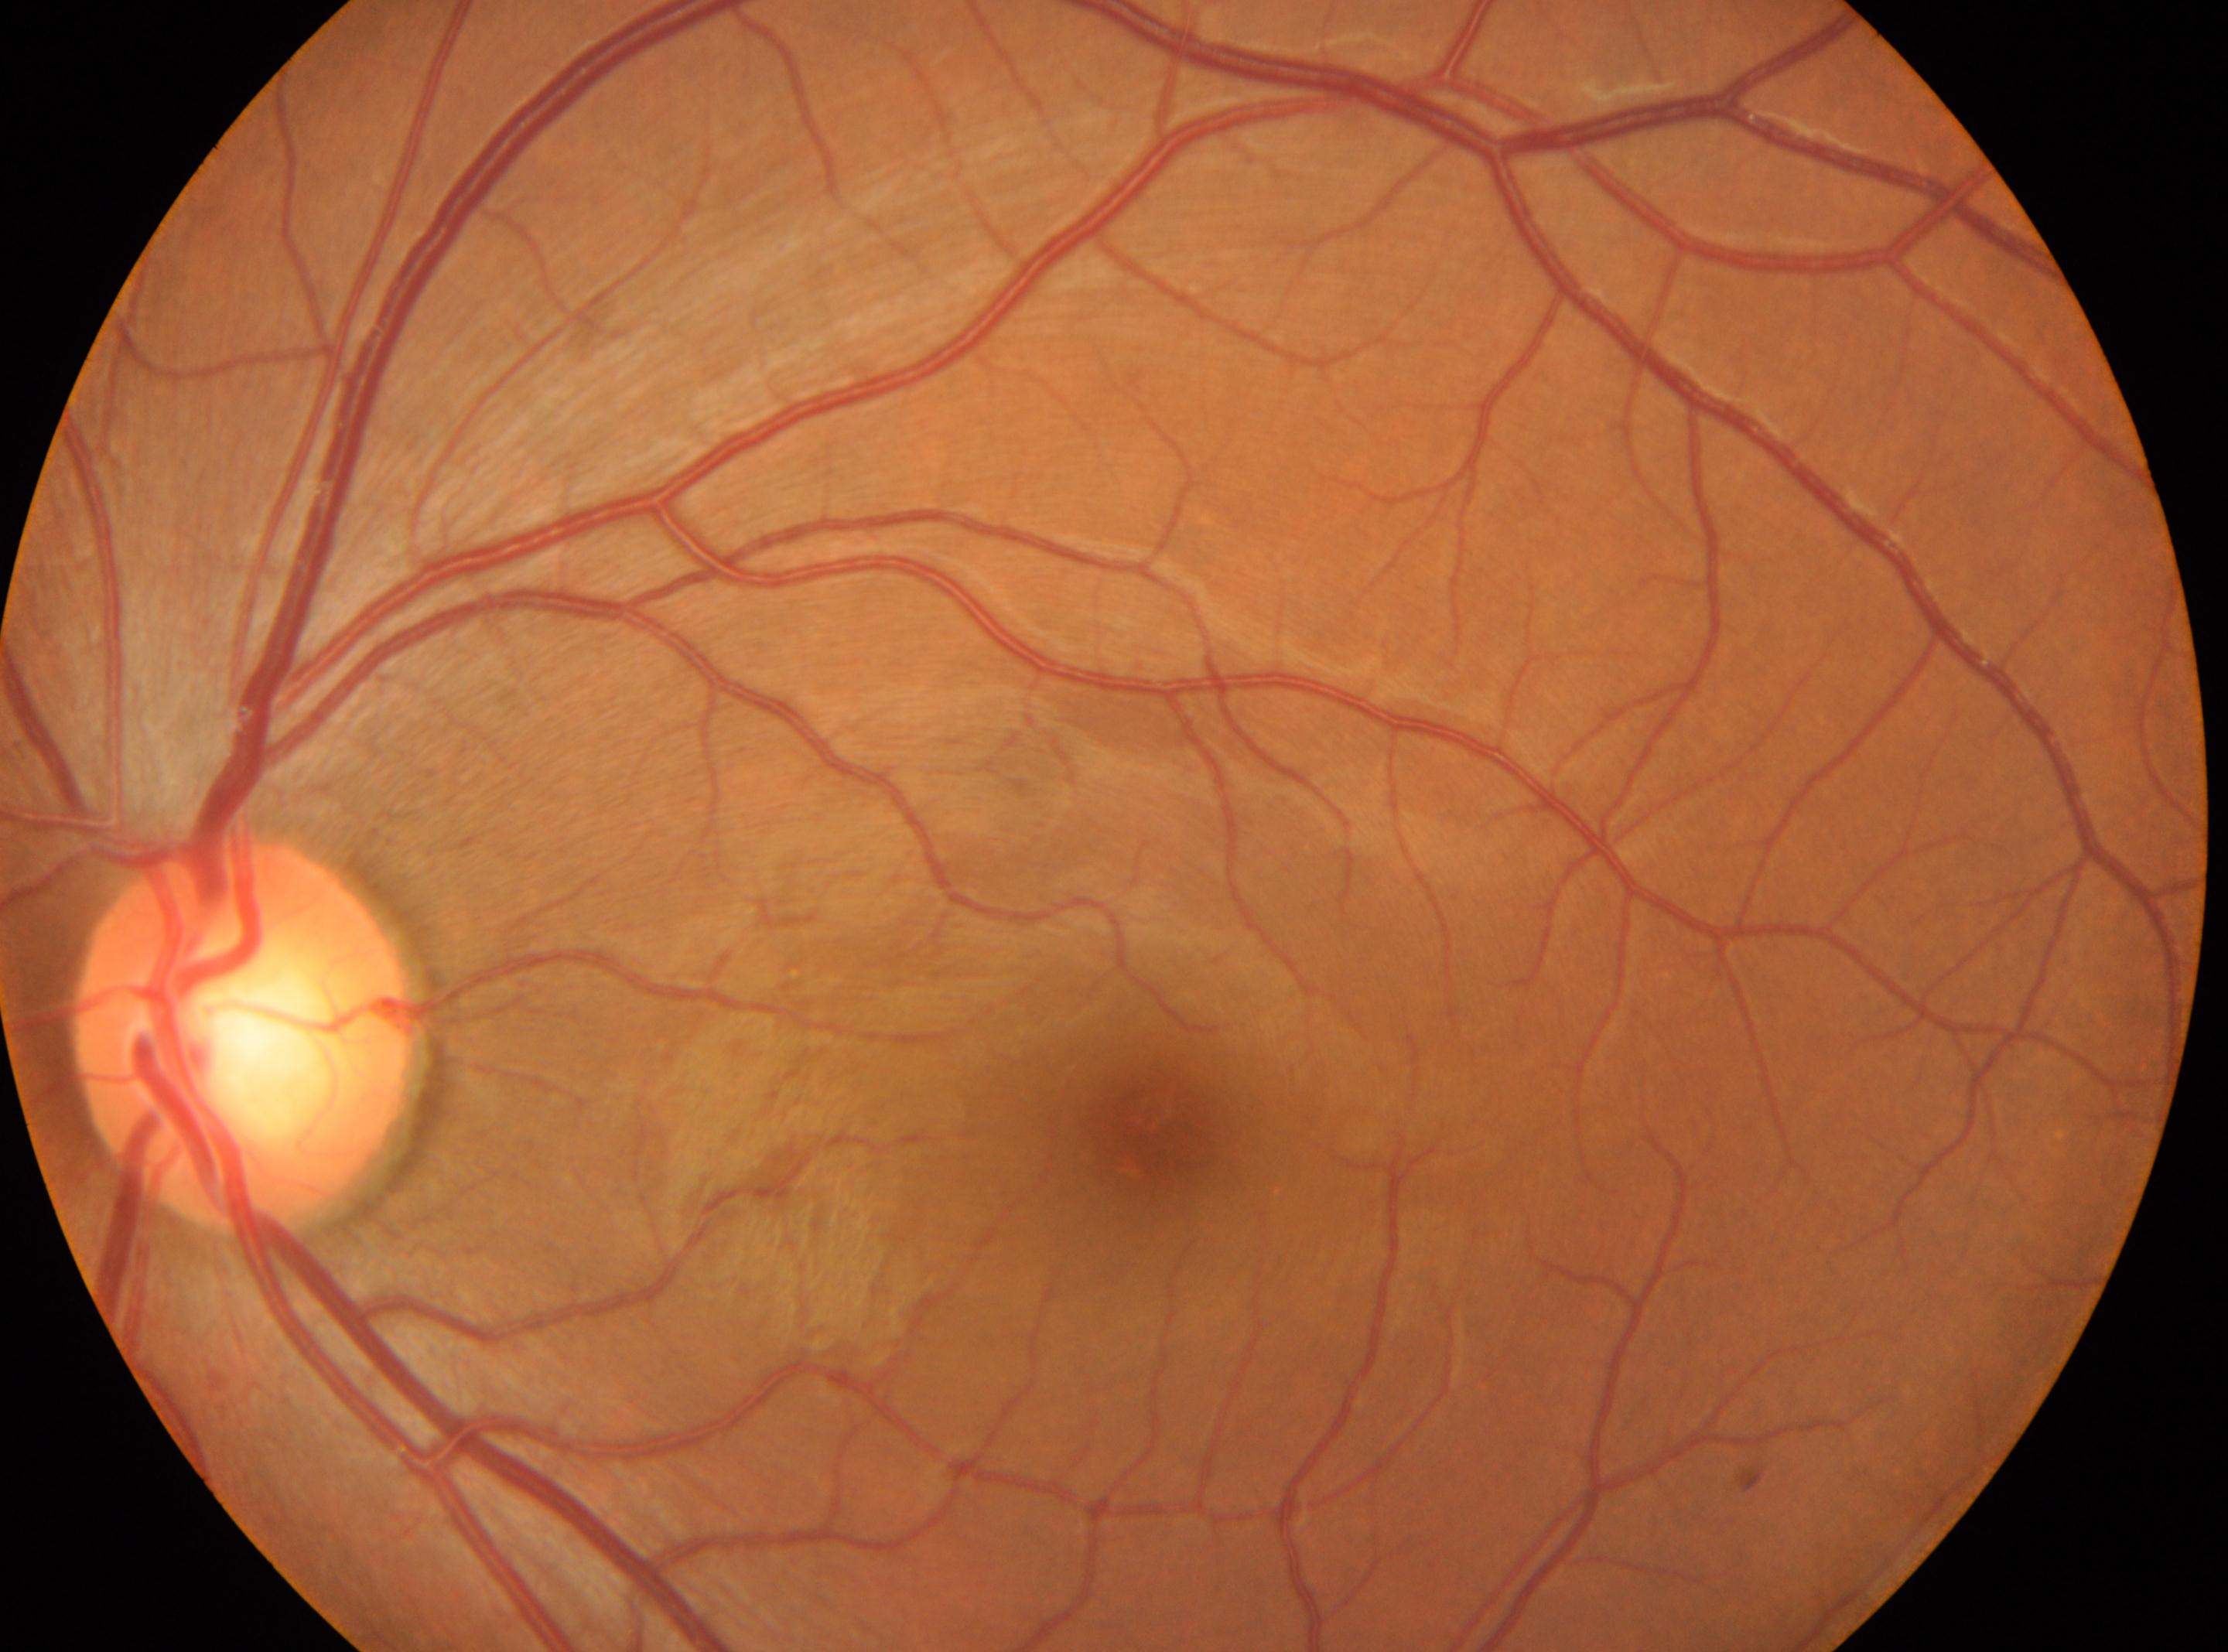 DR: grade 0 (no apparent retinopathy).
Imaged eye: left eye.
Macula center located at (1146,1140).
The optic disc center is at (244,1032).
No DR findings.